1240 by 1240 pixels. Acquired on the Phoenix ICON. Wide-field fundus photograph of an infant: 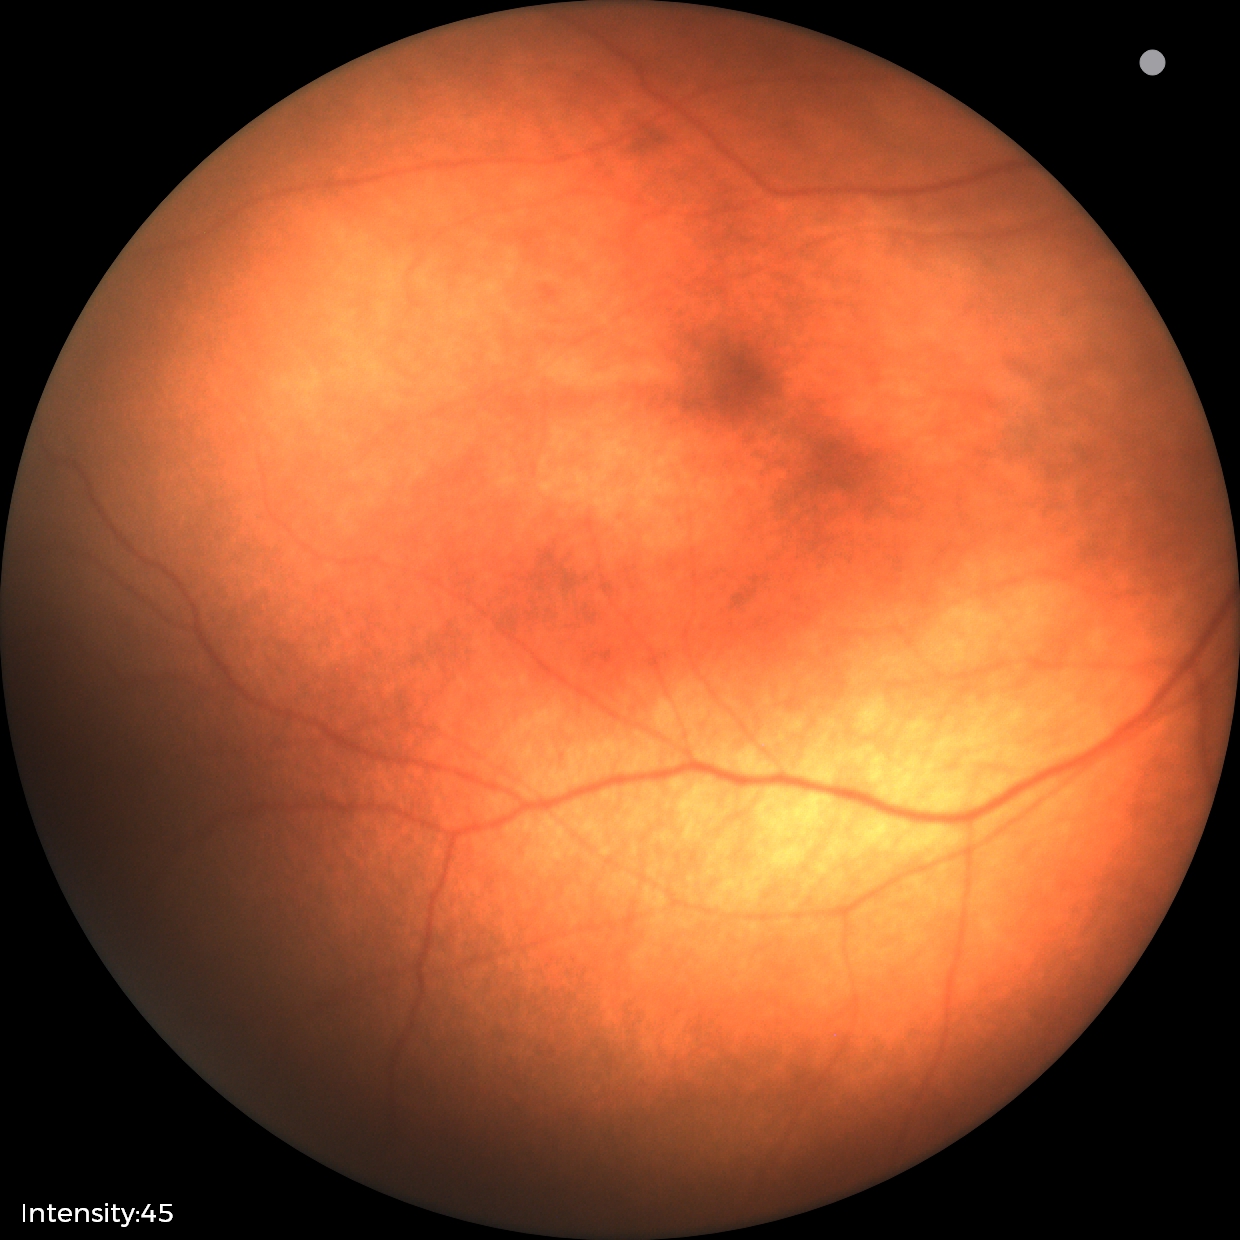 Impression: retinopathy of prematurity stage 2 — ridge with height and width at the demarcation line.